Infant wide-field retinal image; 100° field of view (Phoenix ICON); 1240x1240.
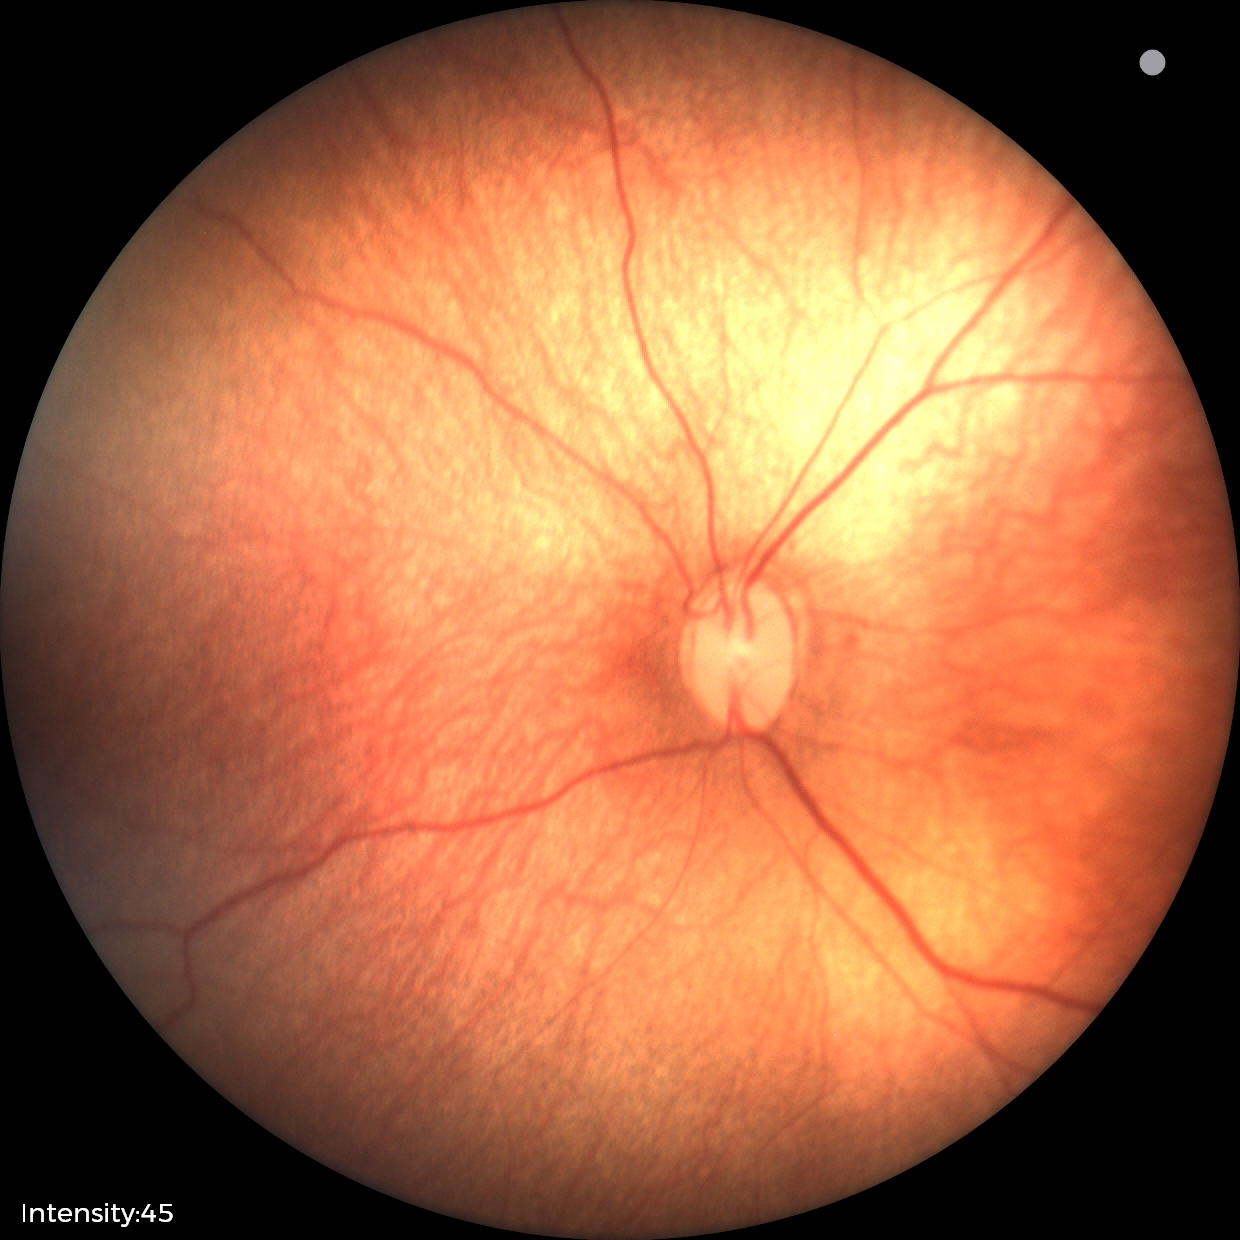 Impression: ROP stage 1.